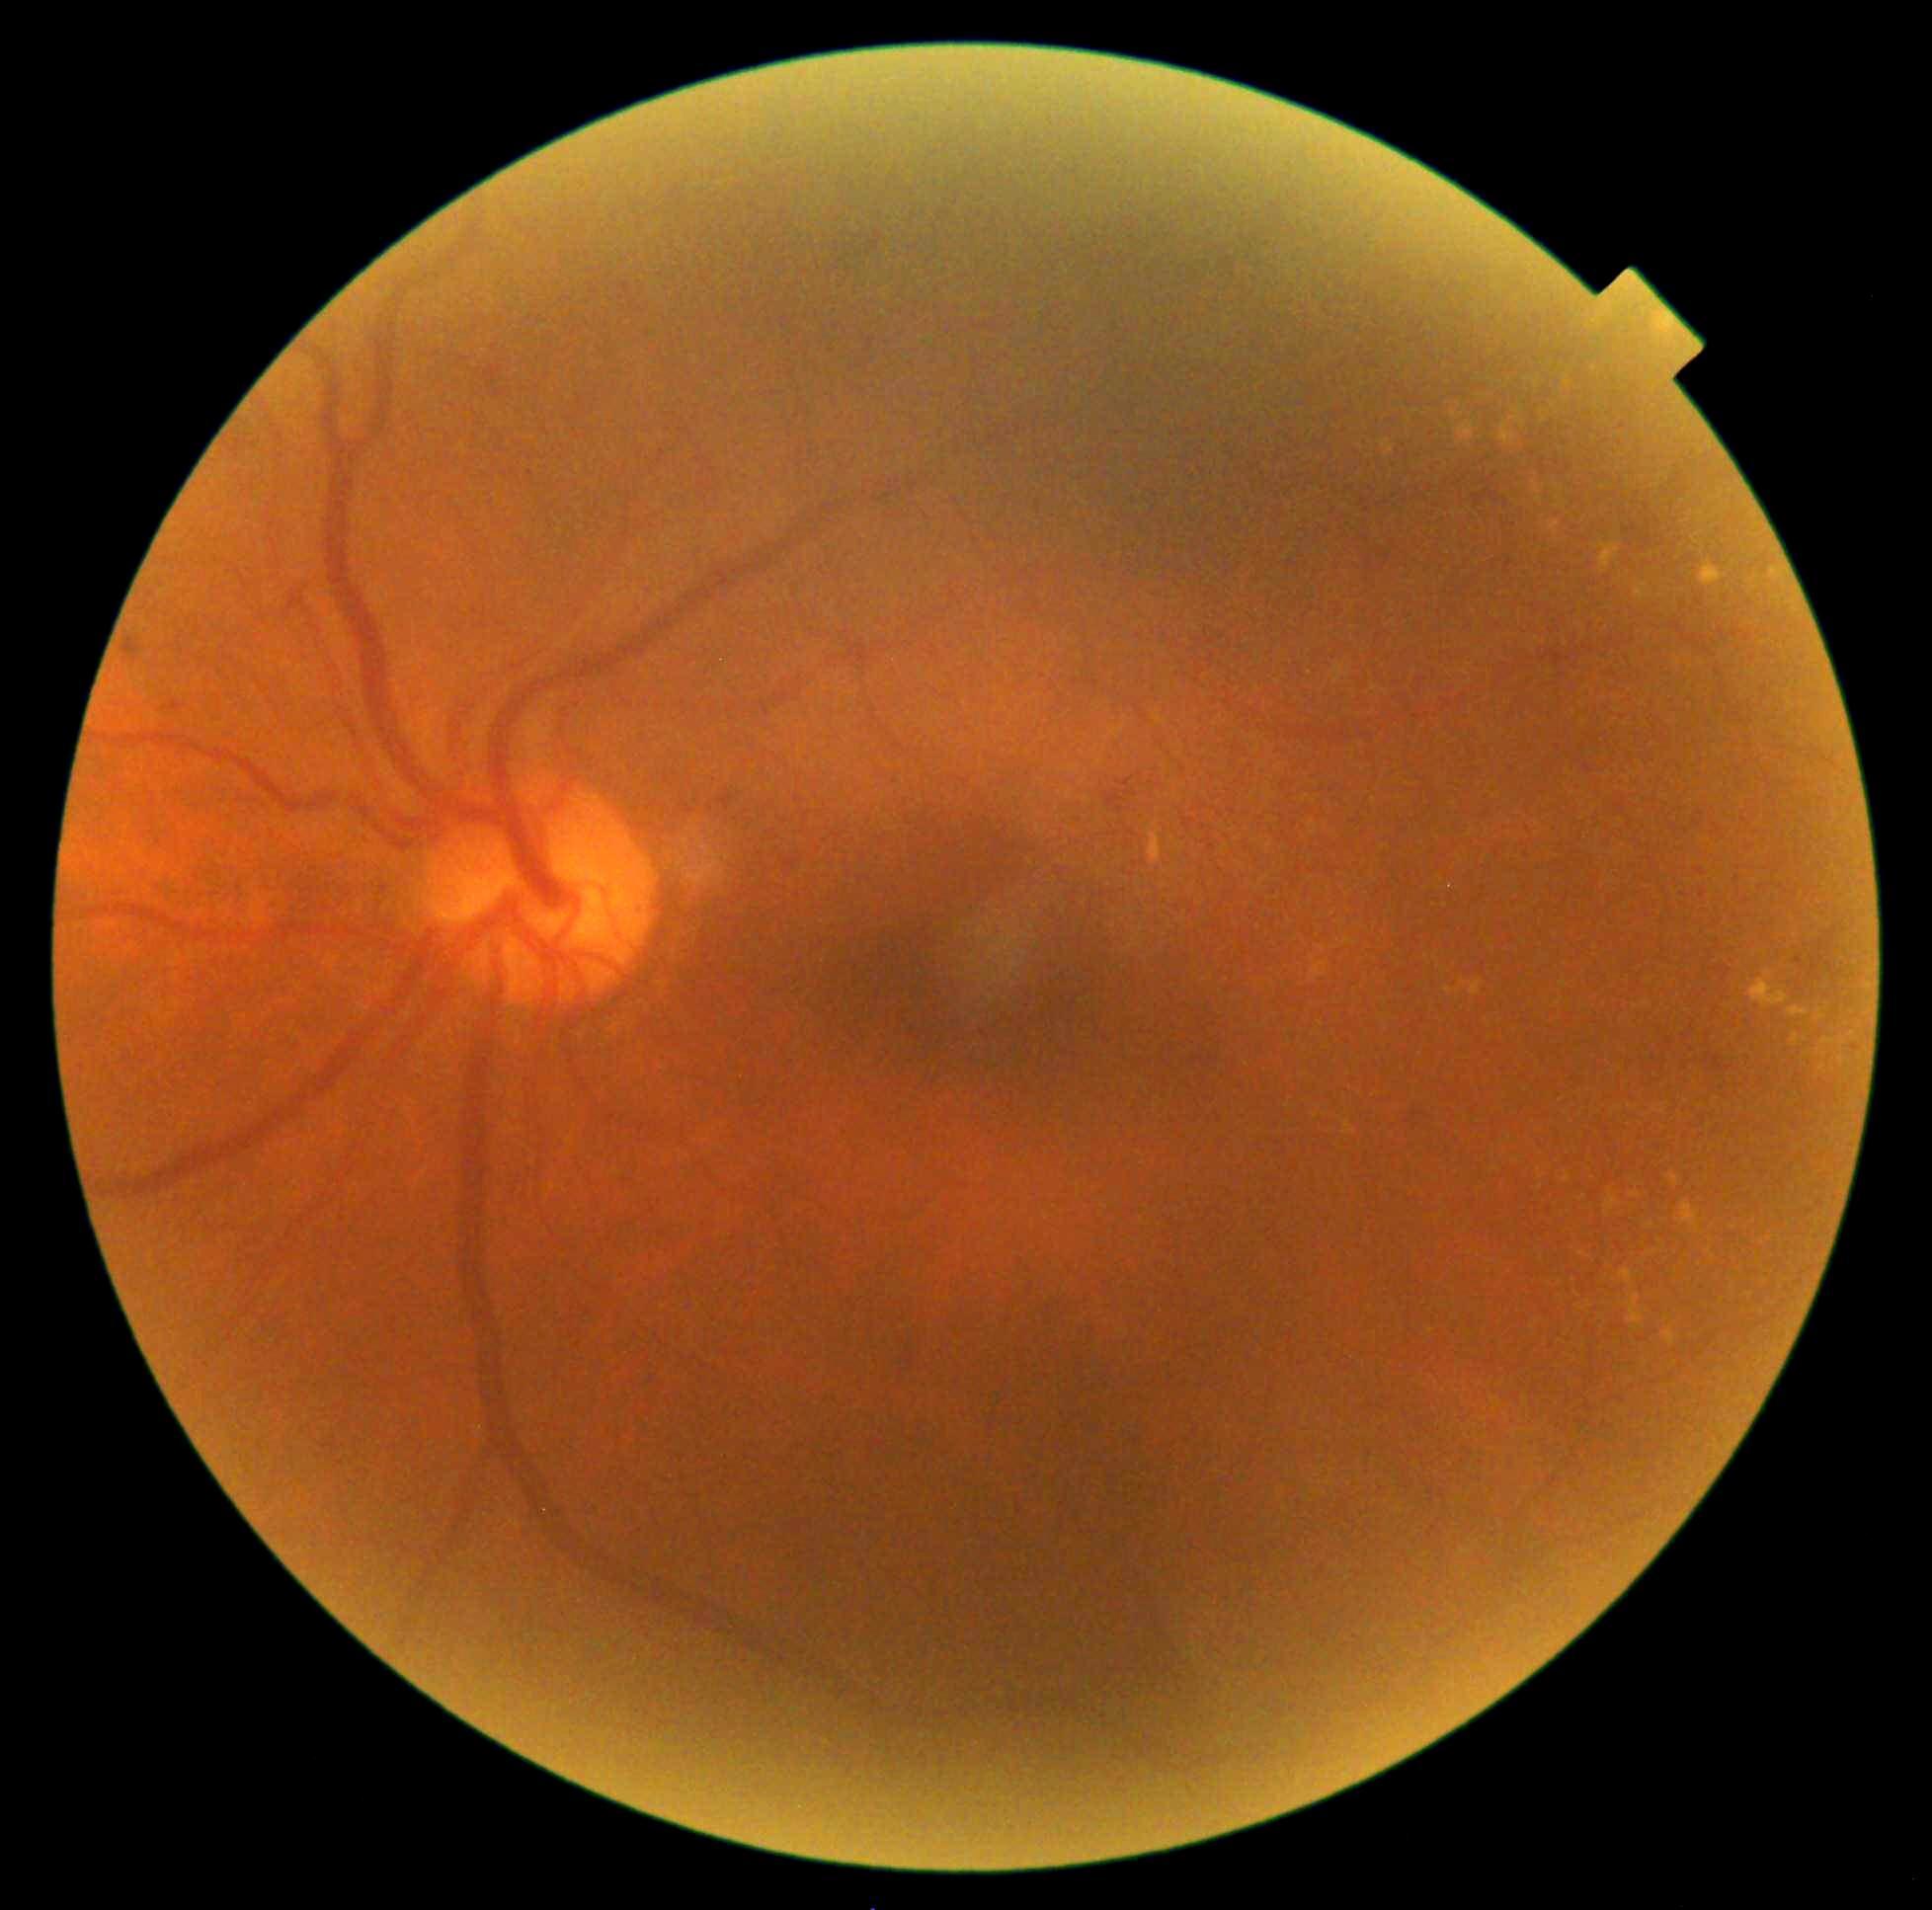 DR stage is grade 2 (moderate NPDR) — more than just microaneurysms but less than severe NPDR. EXs (partial list) at x1=1338, y1=920, x2=1347, y2=924; x1=1533, y1=483, x2=1544, y2=505; x1=1817, y1=1010, x2=1824, y2=1019; x1=1312, y1=962, x2=1328, y2=980; x1=1646, y1=1223, x2=1654, y2=1231; x1=1343, y1=939, x2=1356, y2=946; x1=1605, y1=1189, x2=1621, y2=1216; x1=1667, y1=1173, x2=1680, y2=1187; x1=1599, y1=544, x2=1621, y2=574; x1=1566, y1=377, x2=1570, y2=386. Small EXs approximately at 1542:413; 1778:599; 1544:421; 1594:369; 1464:983.